45° FOV. Color fundus image. NIDEK AFC-230. Nonmydriatic fundus photograph. Image size 848x848
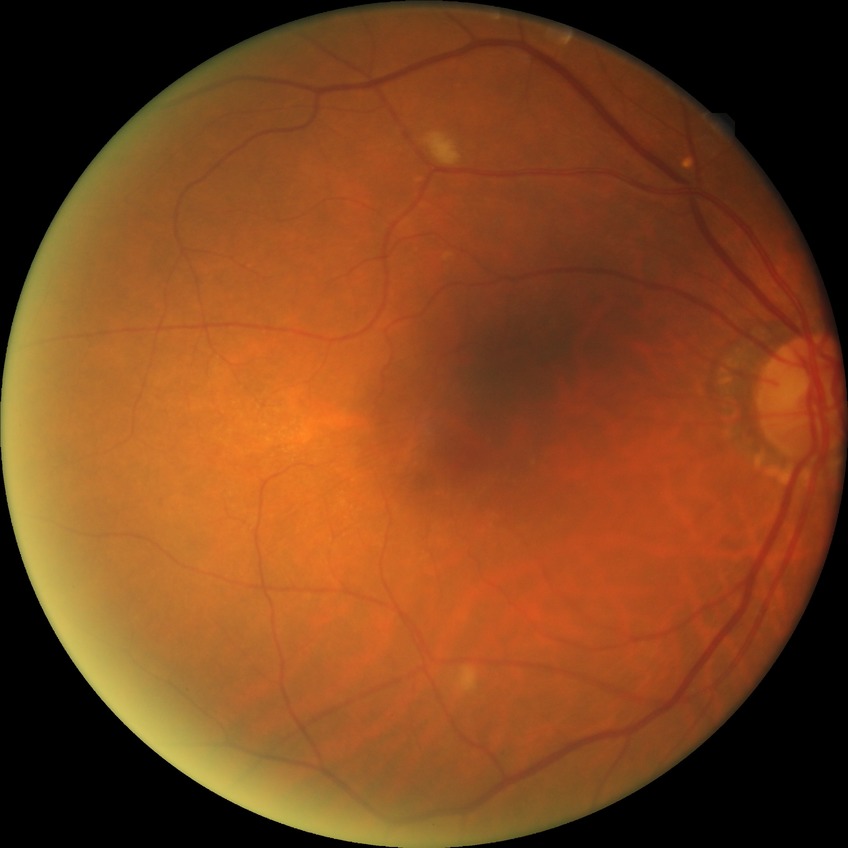 • DR class — non-proliferative diabetic retinopathy
• DR severity — PPDR